Retinal fundus photograph: 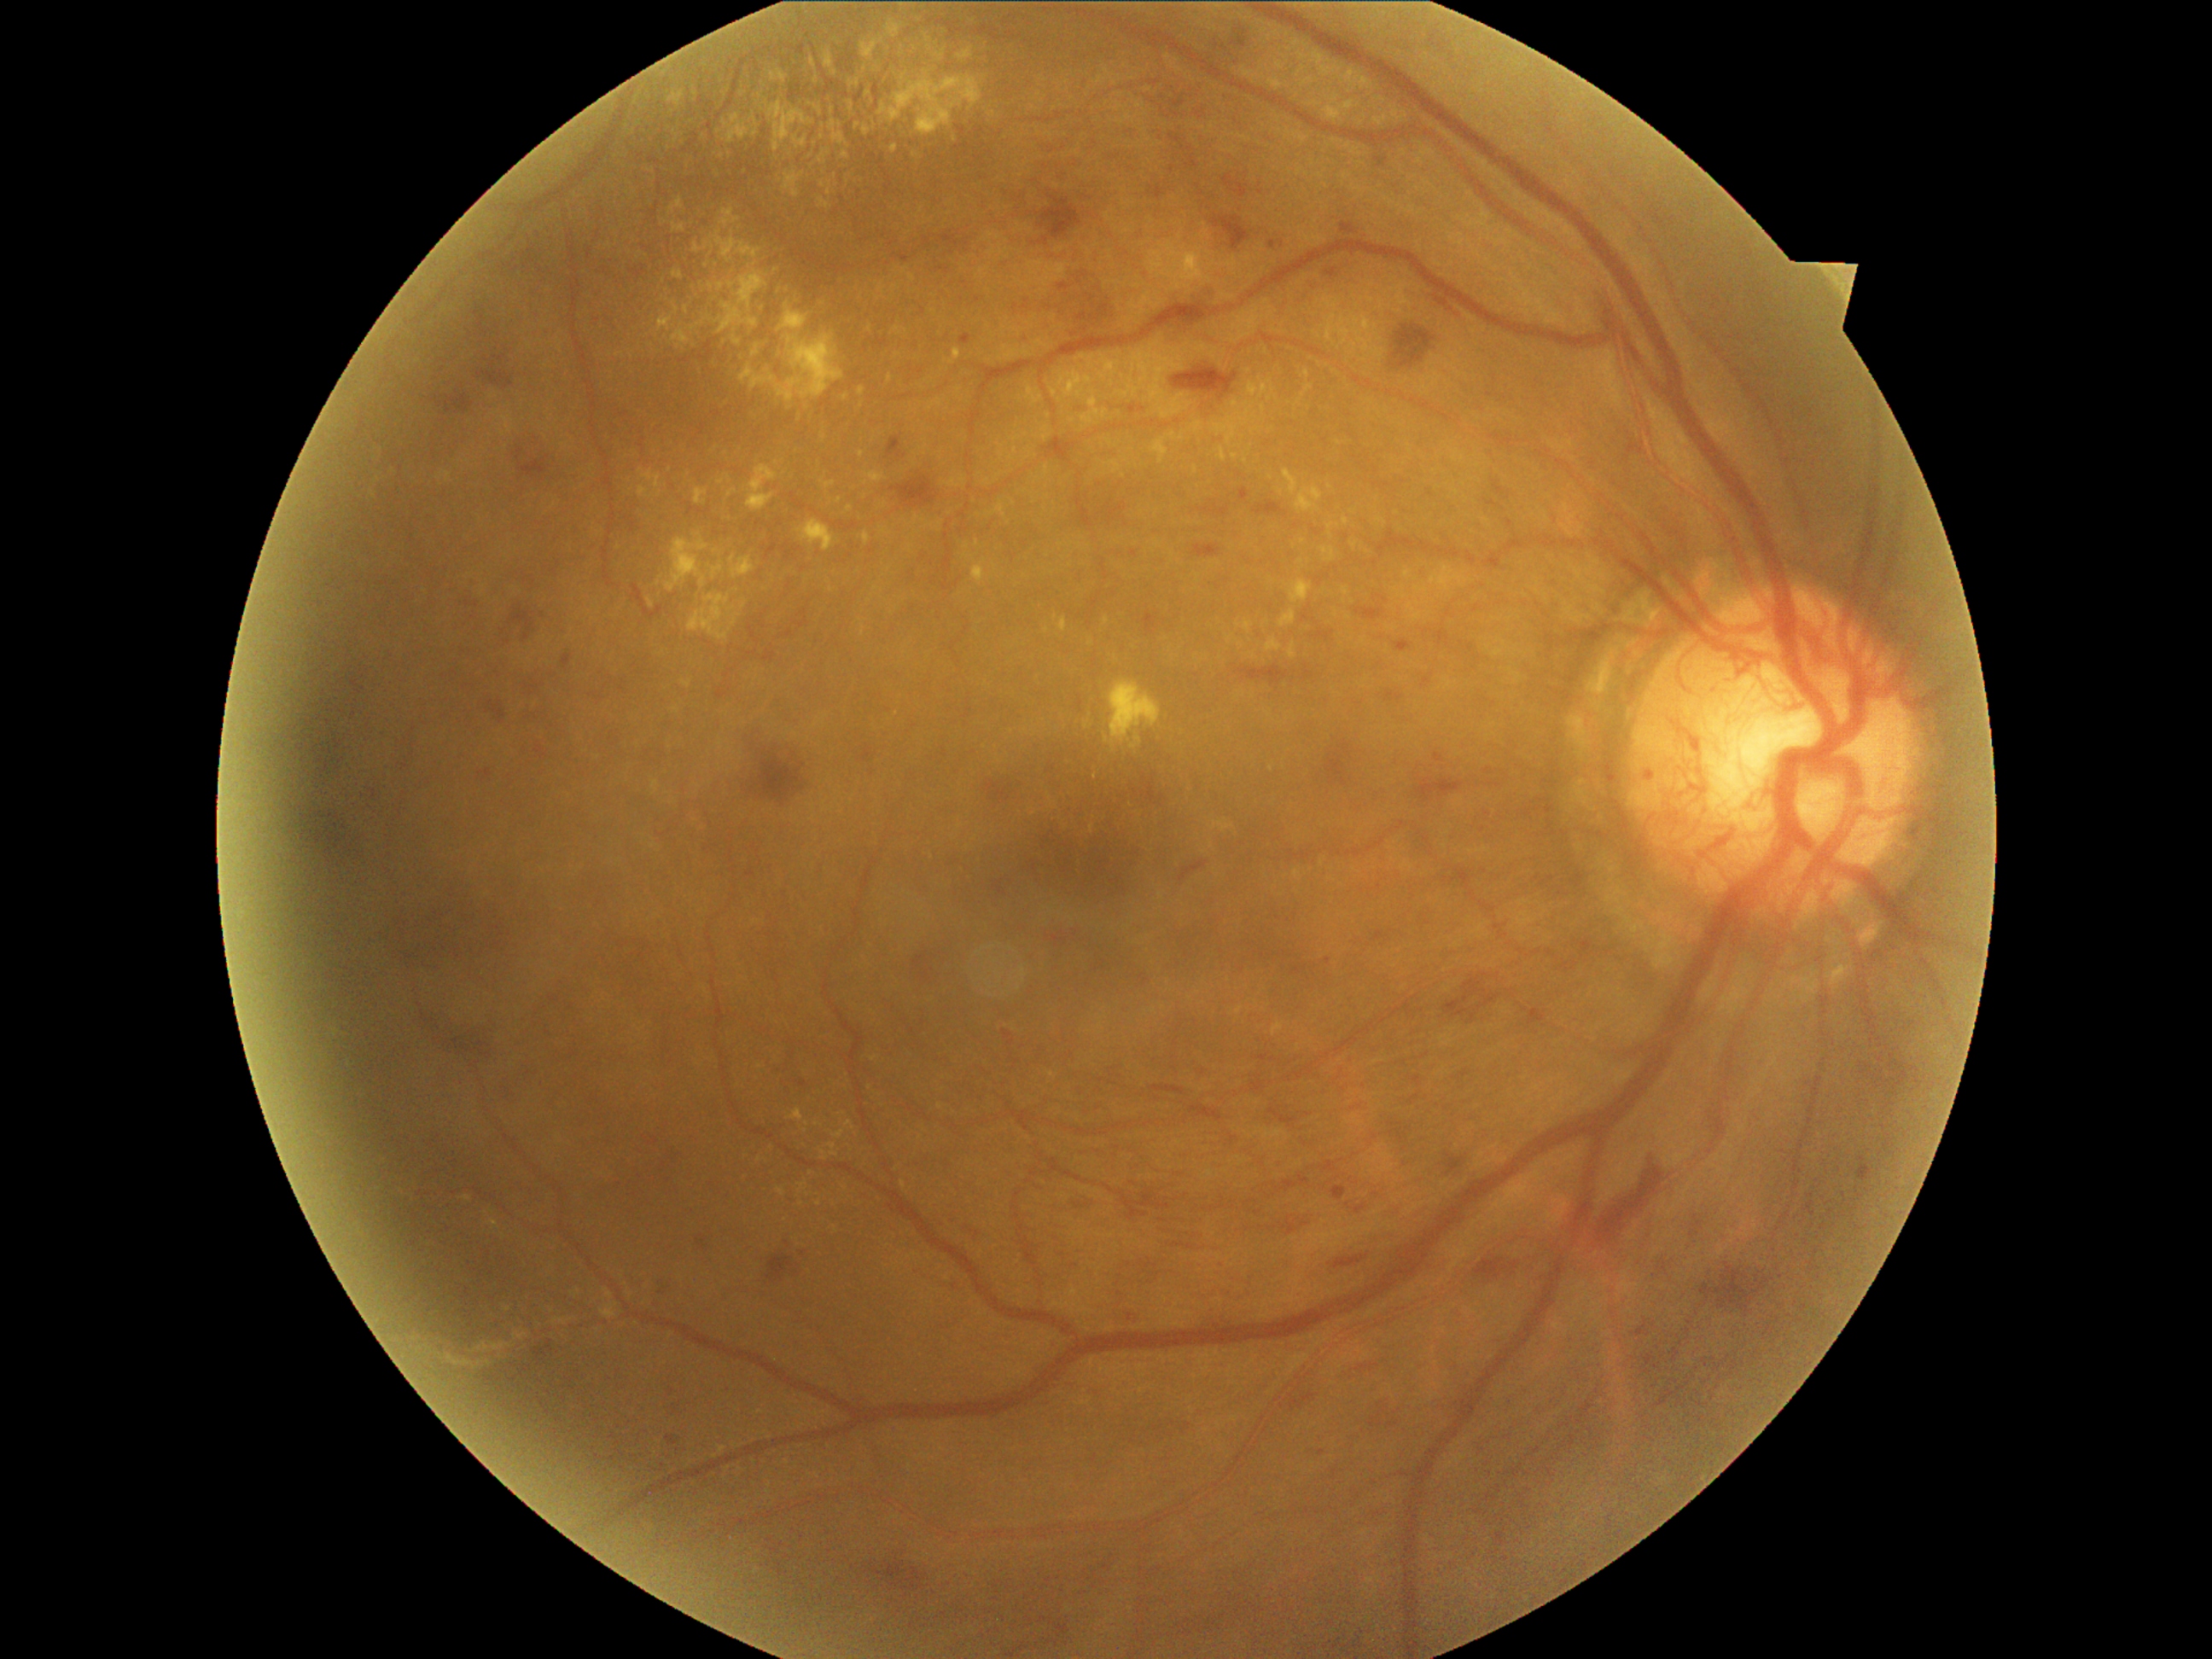

Retinopathy grade: PDR (4) — neovascularization and/or vitreous/pre-retinal hemorrhage
Selected lesions:
hemorrhages (subset) = 1238/1179/1274/1204; 311/731/346/789; 943/235/969/248; 344/846/354/853; 301/803/349/866; 1052/257/1114/337; 887/436/905/458; 371/789/376/798; 1289/1392/1318/1412; 1334/1255/1370/1269; 1373/931/1387/943; 1047/936/1068/946; 310/791/327/800; 1117/1190/1170/1221; 518/446/550/479; 1143/612/1158/636
Small hemorrhages approximately at (322; 704)
hard exudates (subset) = 1100/368/1110/376; 1059/619/1068/632; 723/114/750/146; 888/375/894/383; 798/402/806/428; 784/172/805/197; 1327/95/1339/103; 846/506/854/513; 1363/317/1378/327; 864/125/871/136; 1390/105/1407/120; 789/1110/805/1122; 1103/678/1161/750; 1076/381/1088/409
Small hard exudates approximately at (722; 483); (845; 156); (823; 127); (896; 287); (1090; 643); (723; 157)